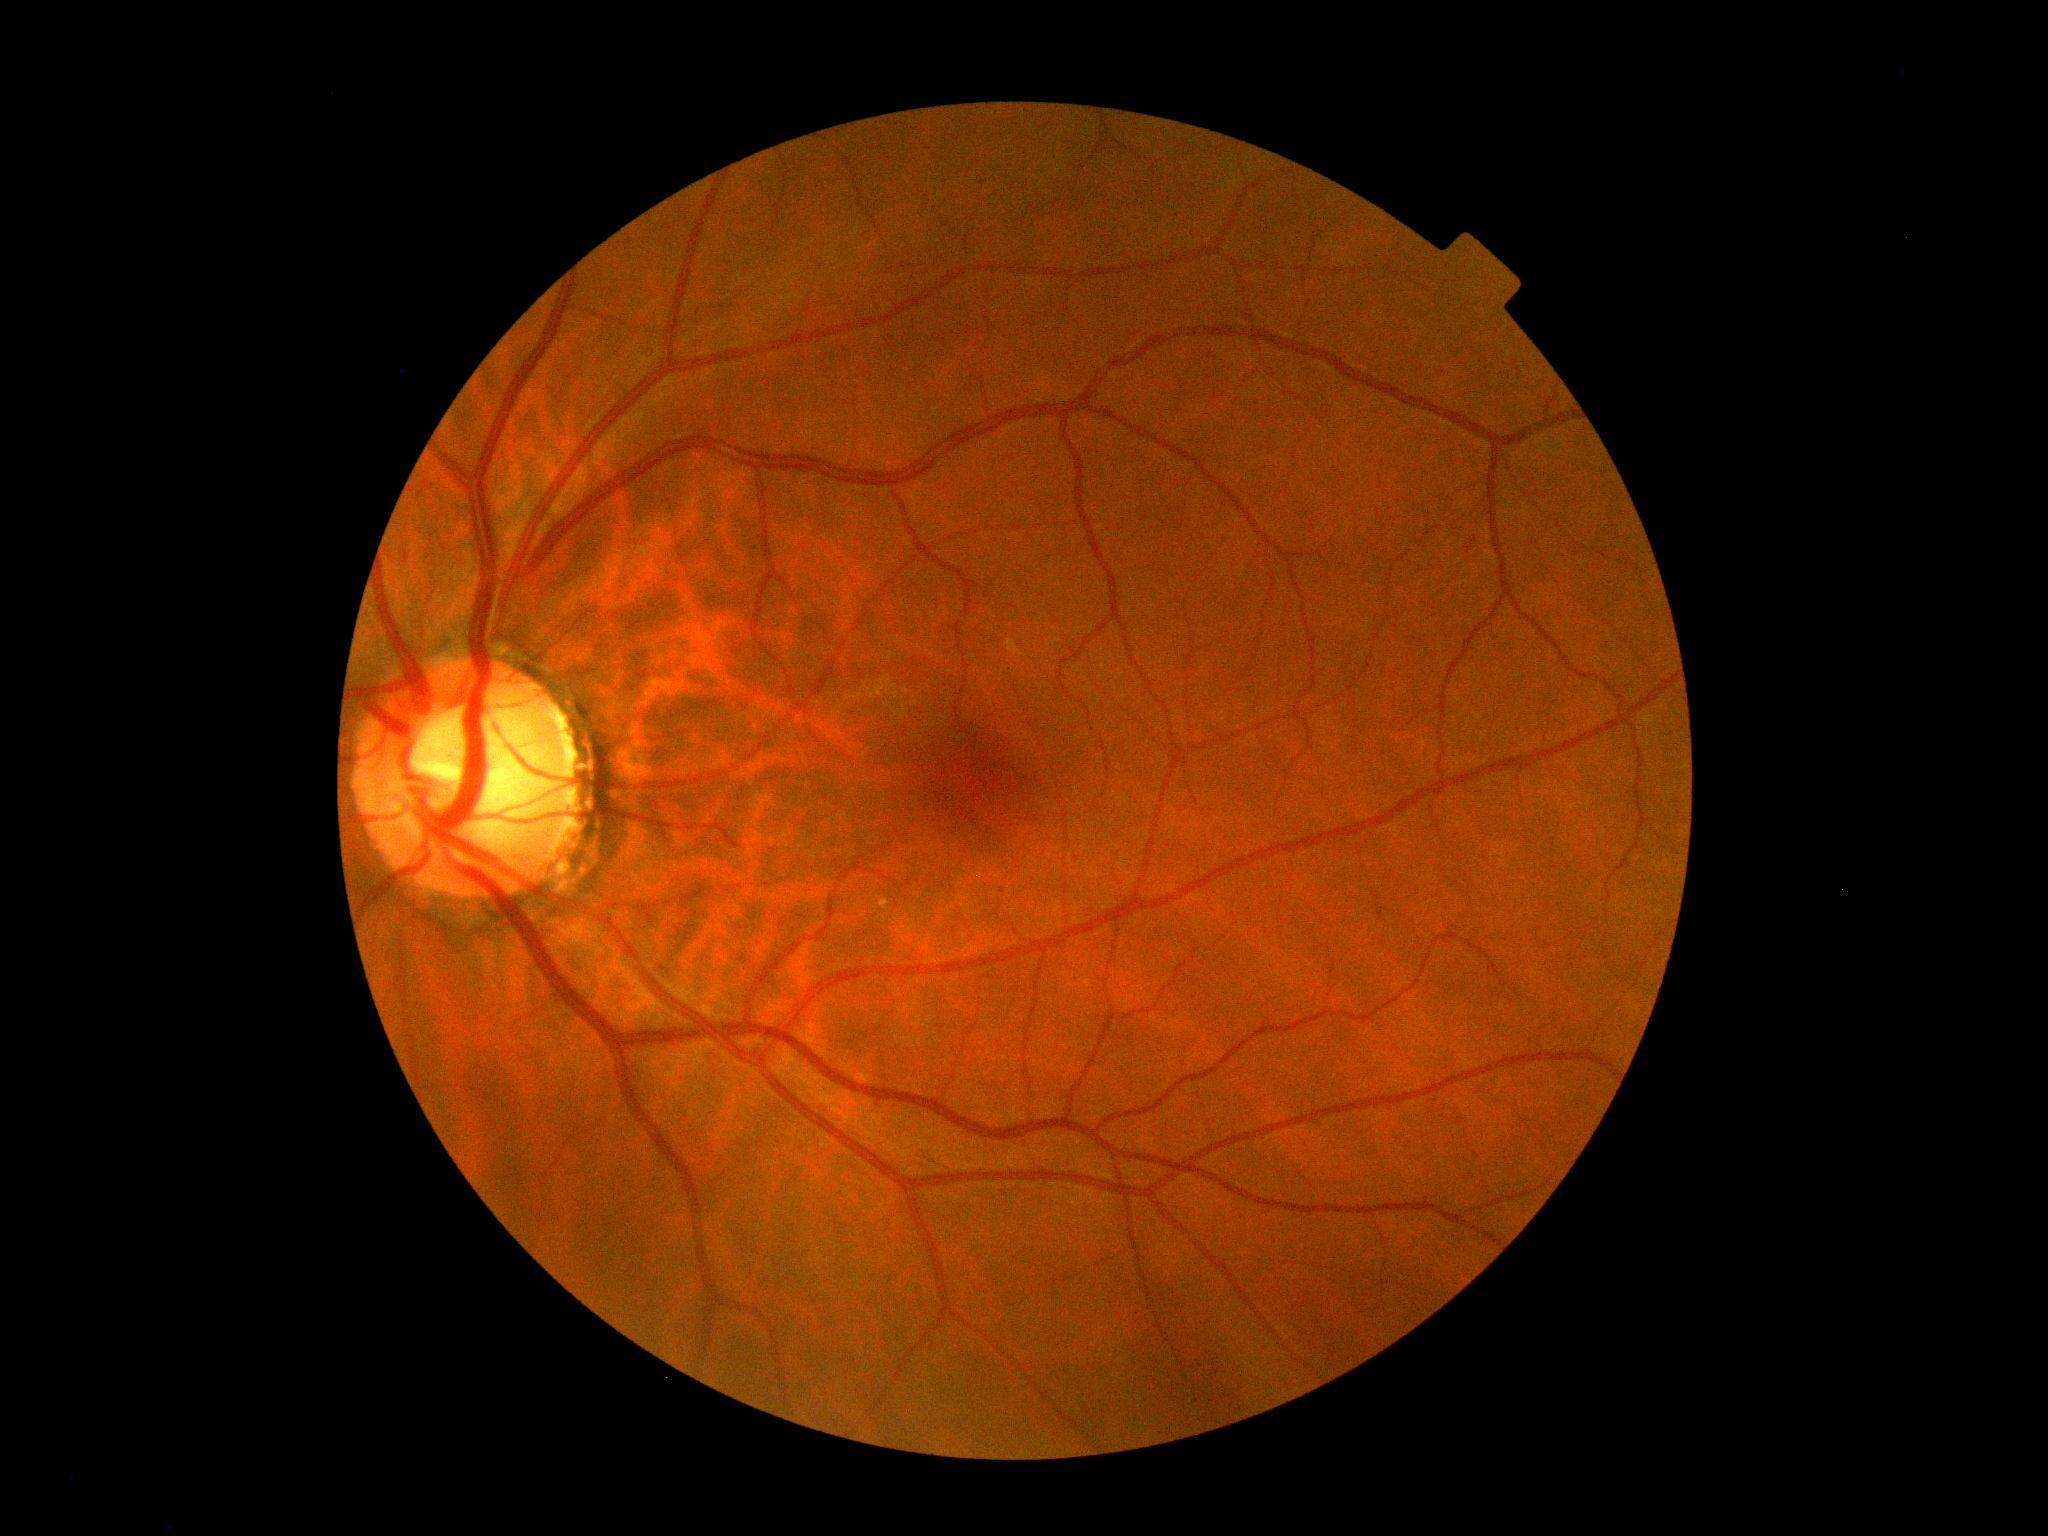

diabetic retinopathy (DR): grade 0 (no apparent retinopathy).